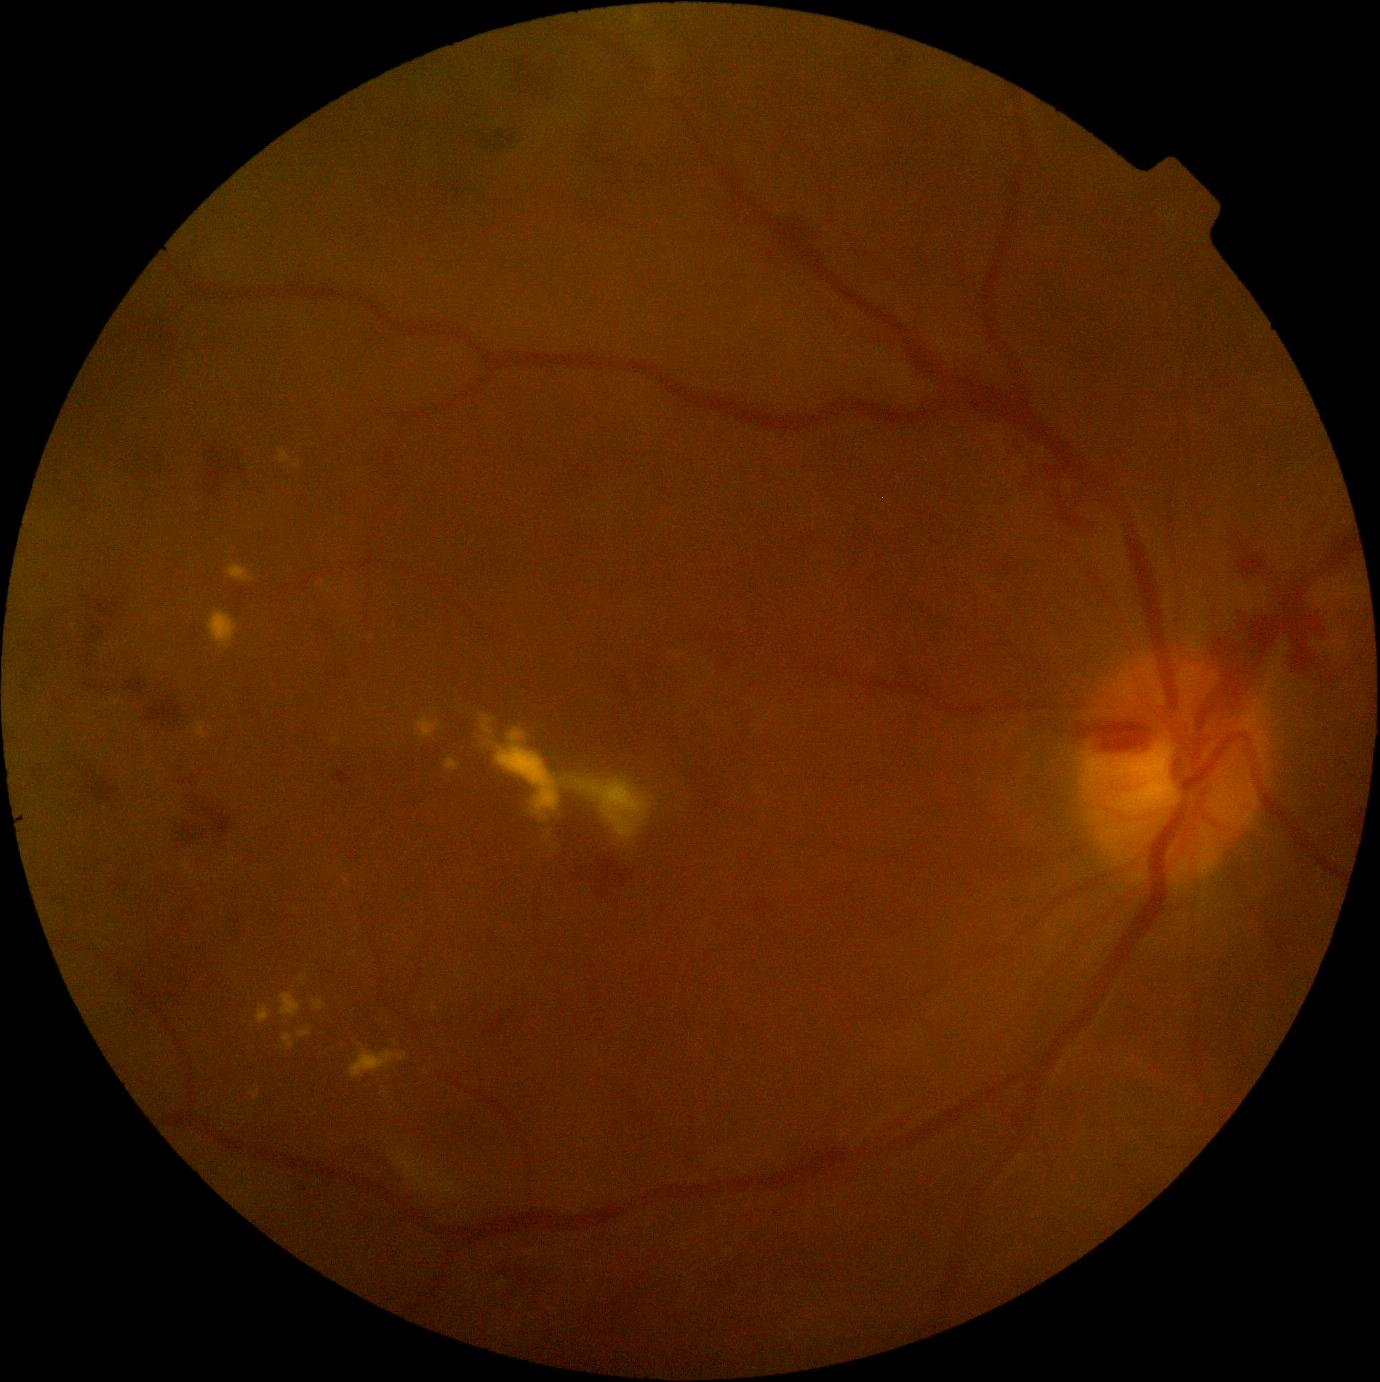
• diabetic retinopathy (DR) — 2/4
• DR class — non-proliferative diabetic retinopathy